45° field of view · image size 848x848 · NIDEK AFC-230 fundus camera · color fundus photograph · without pupil dilation: 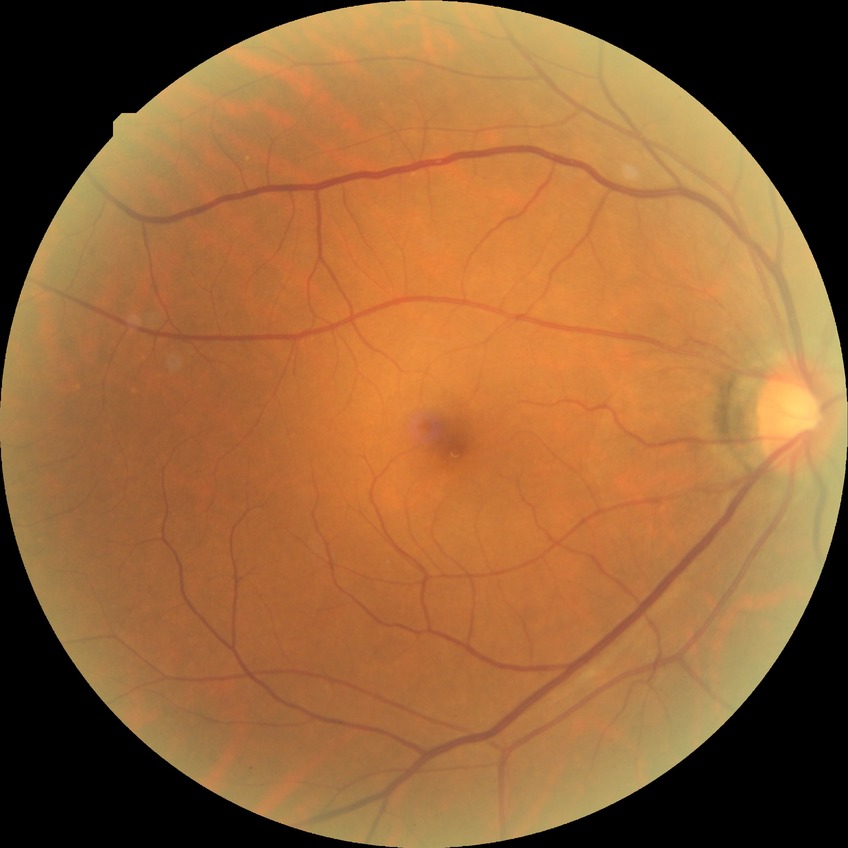
Modified Davis grading is no diabetic retinopathy.